Fundus photo taken with a portable handheld camera
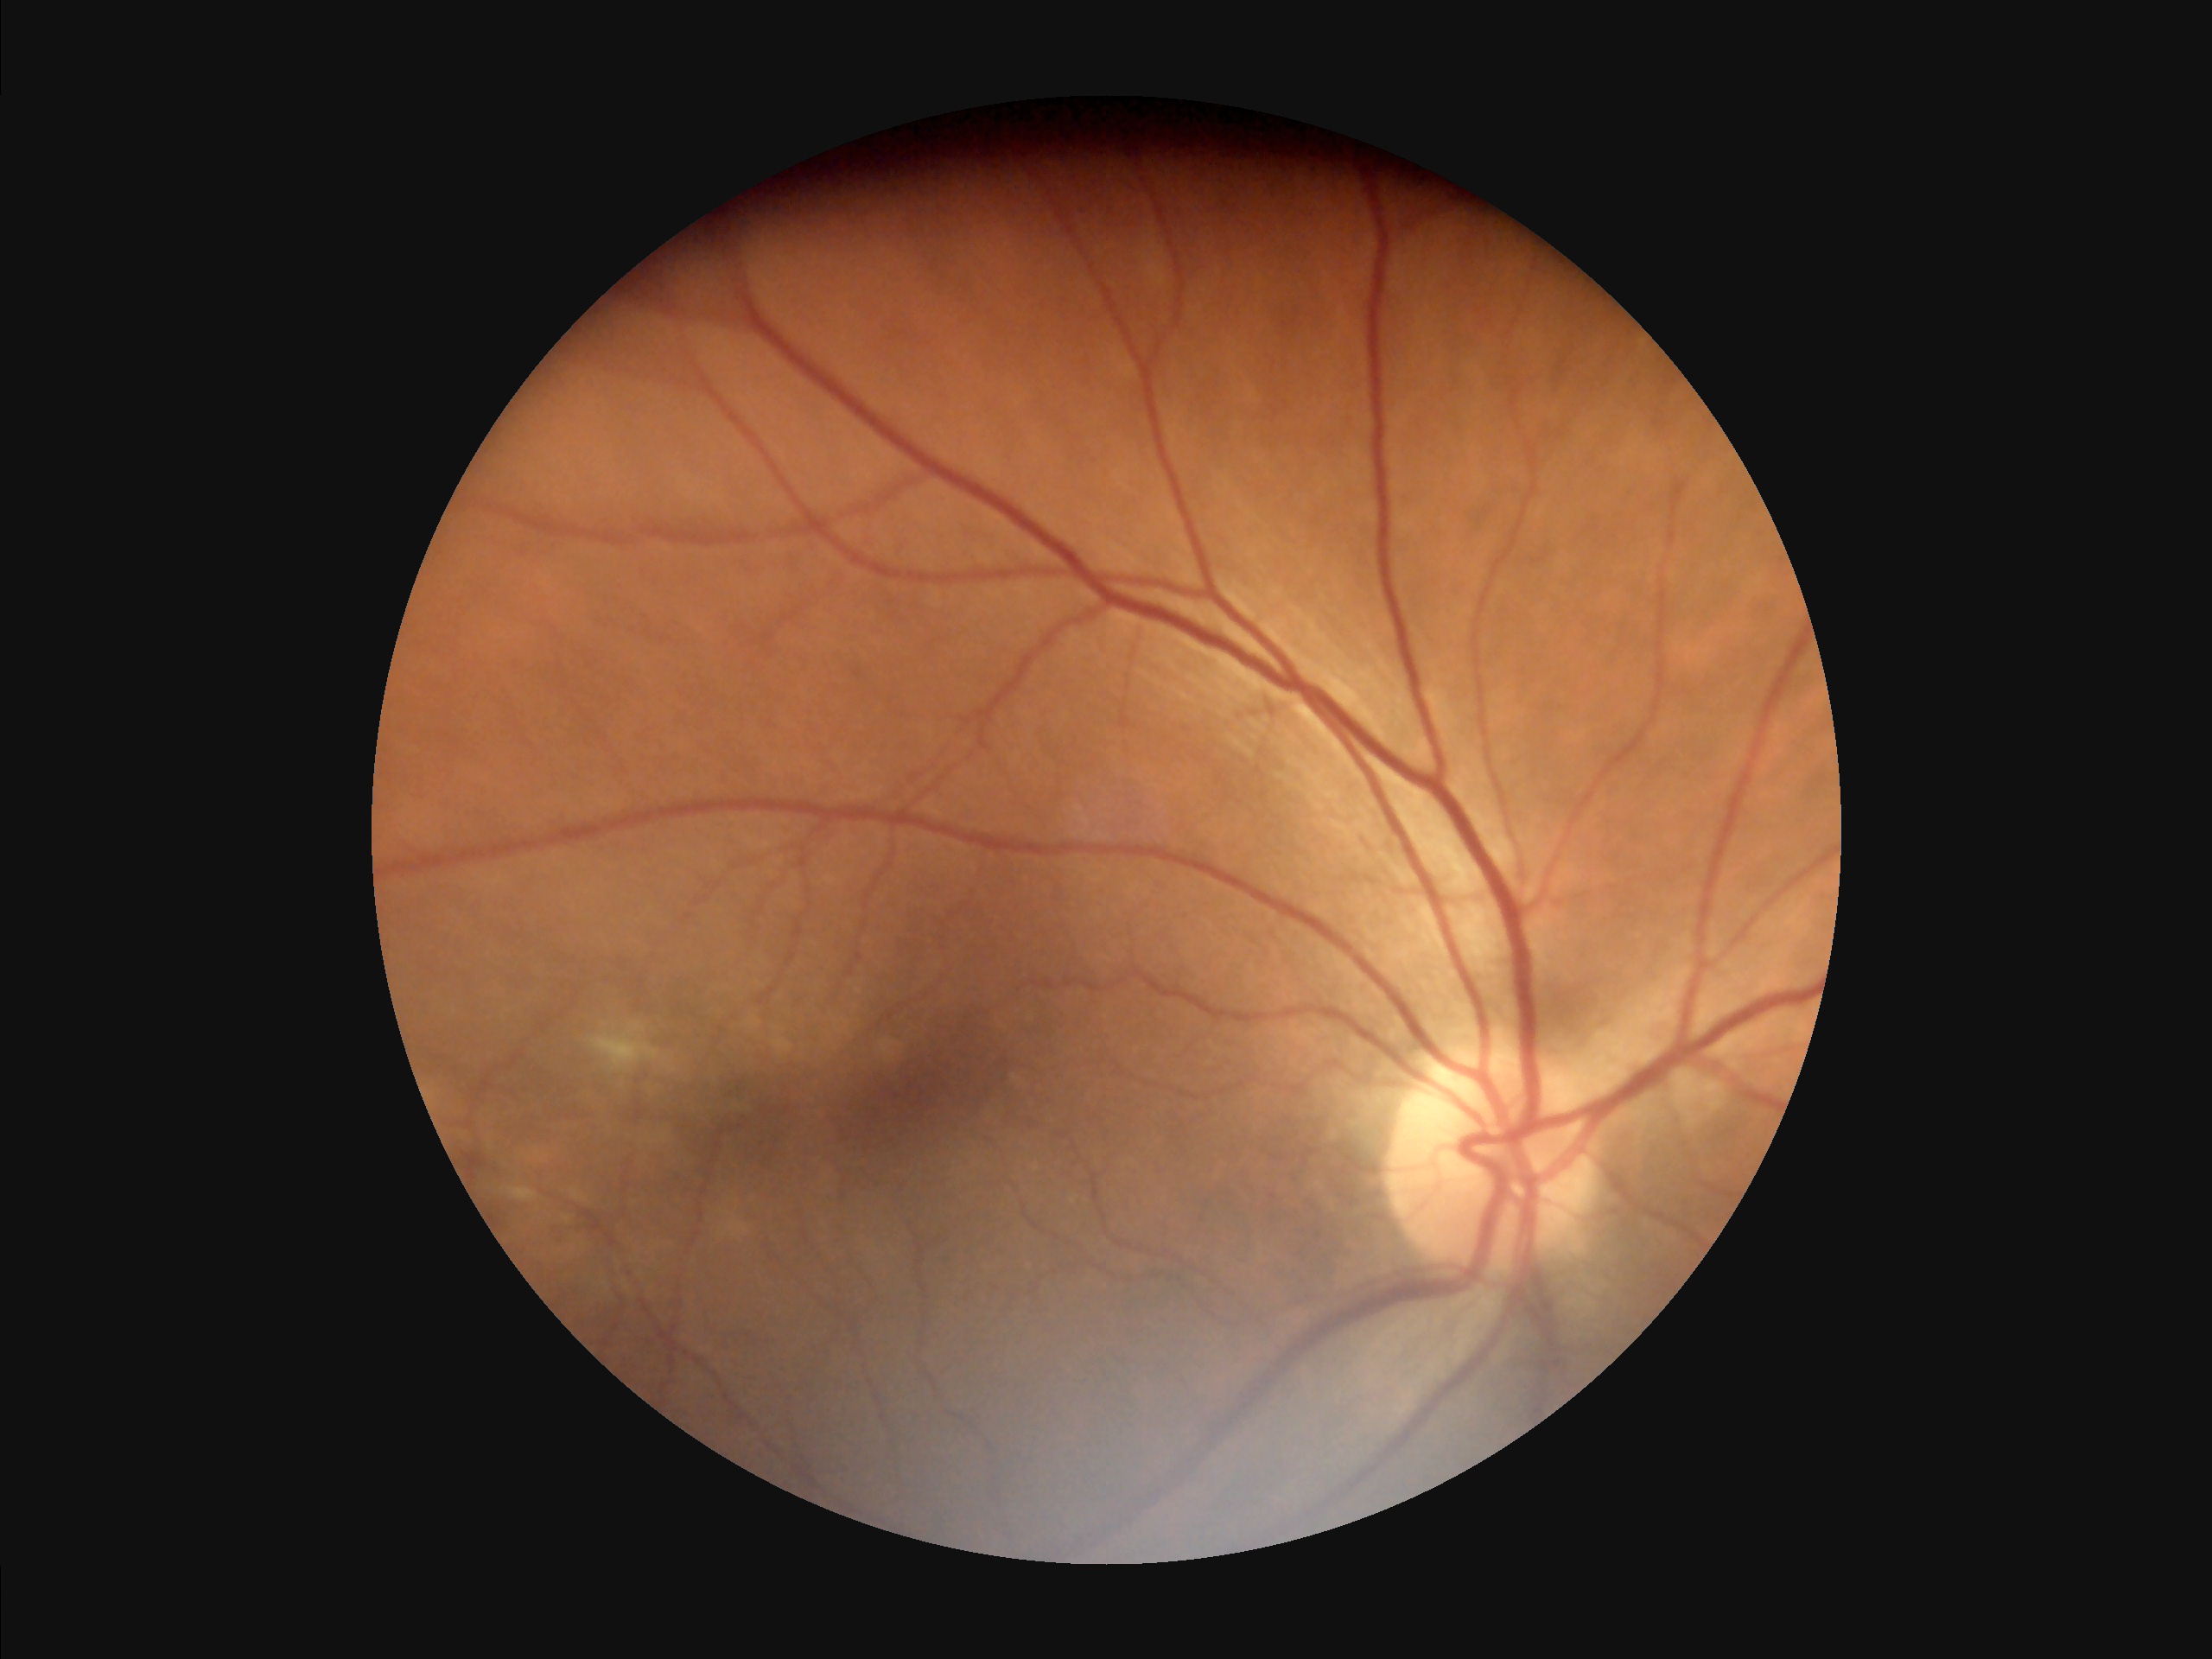 {
  "overall_quality": "satisfactory",
  "contrast": "good",
  "illumination": "even"
}